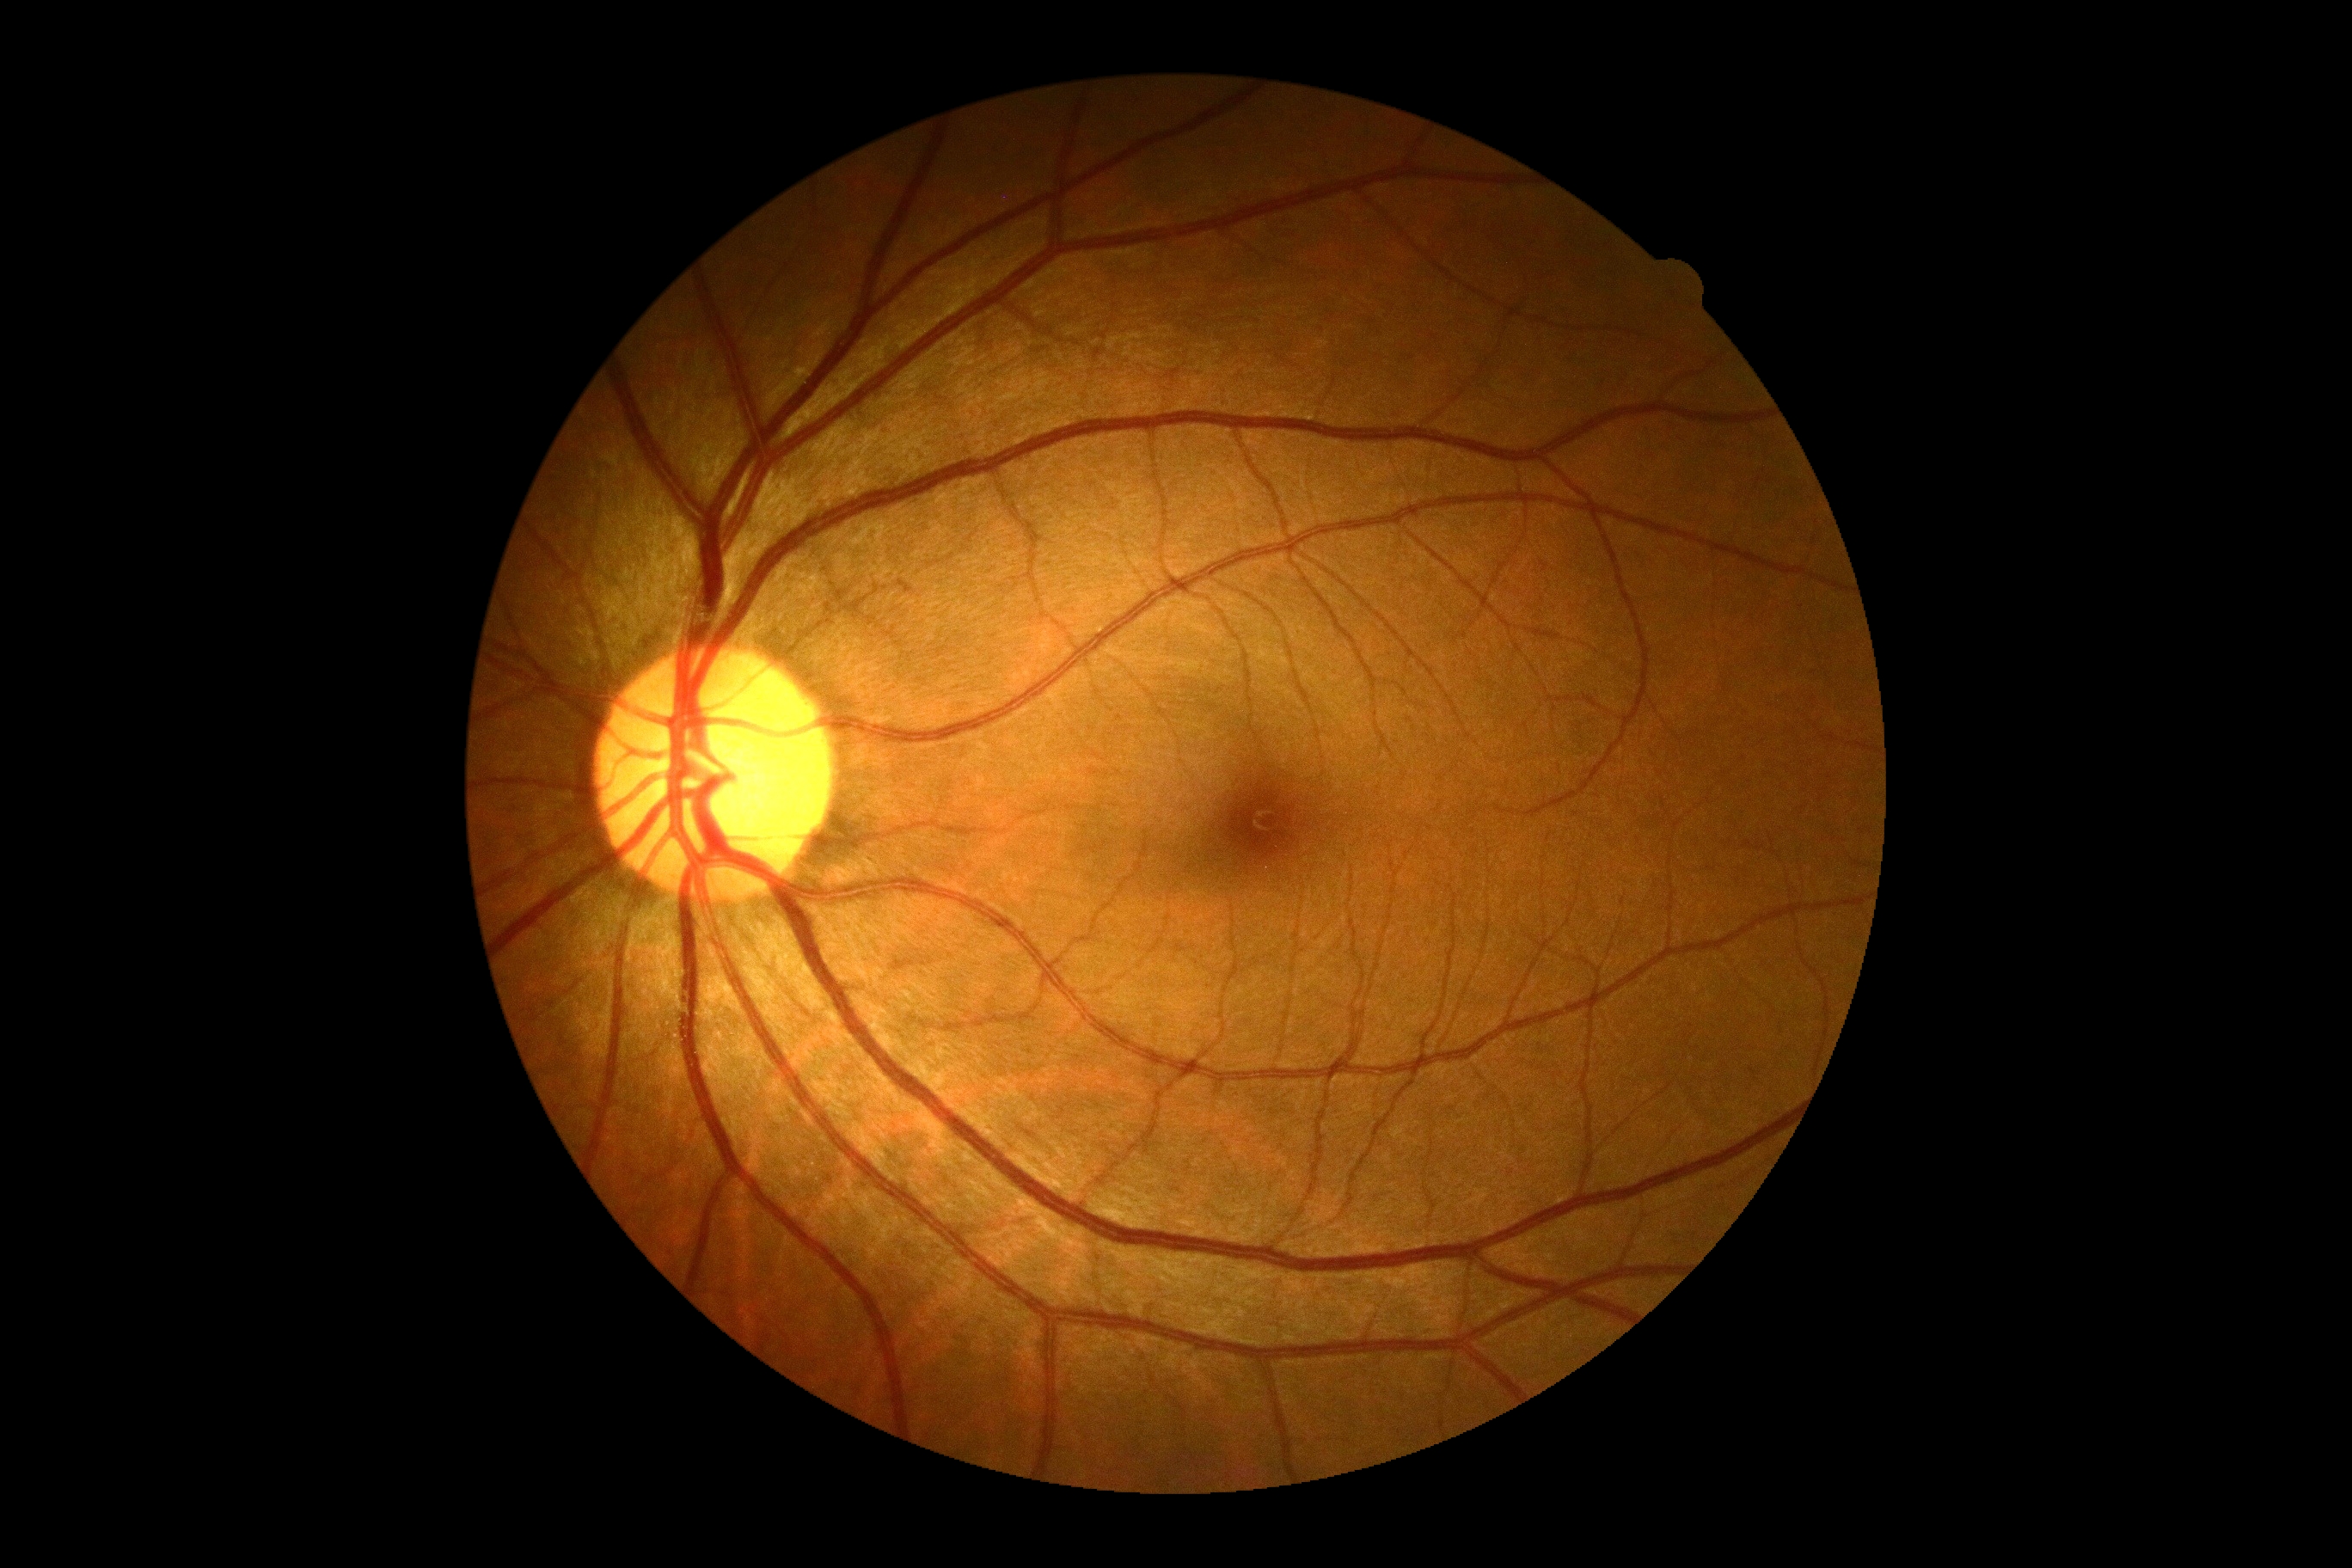 DR severity is 0.